Fundus photo. 45° field of view:
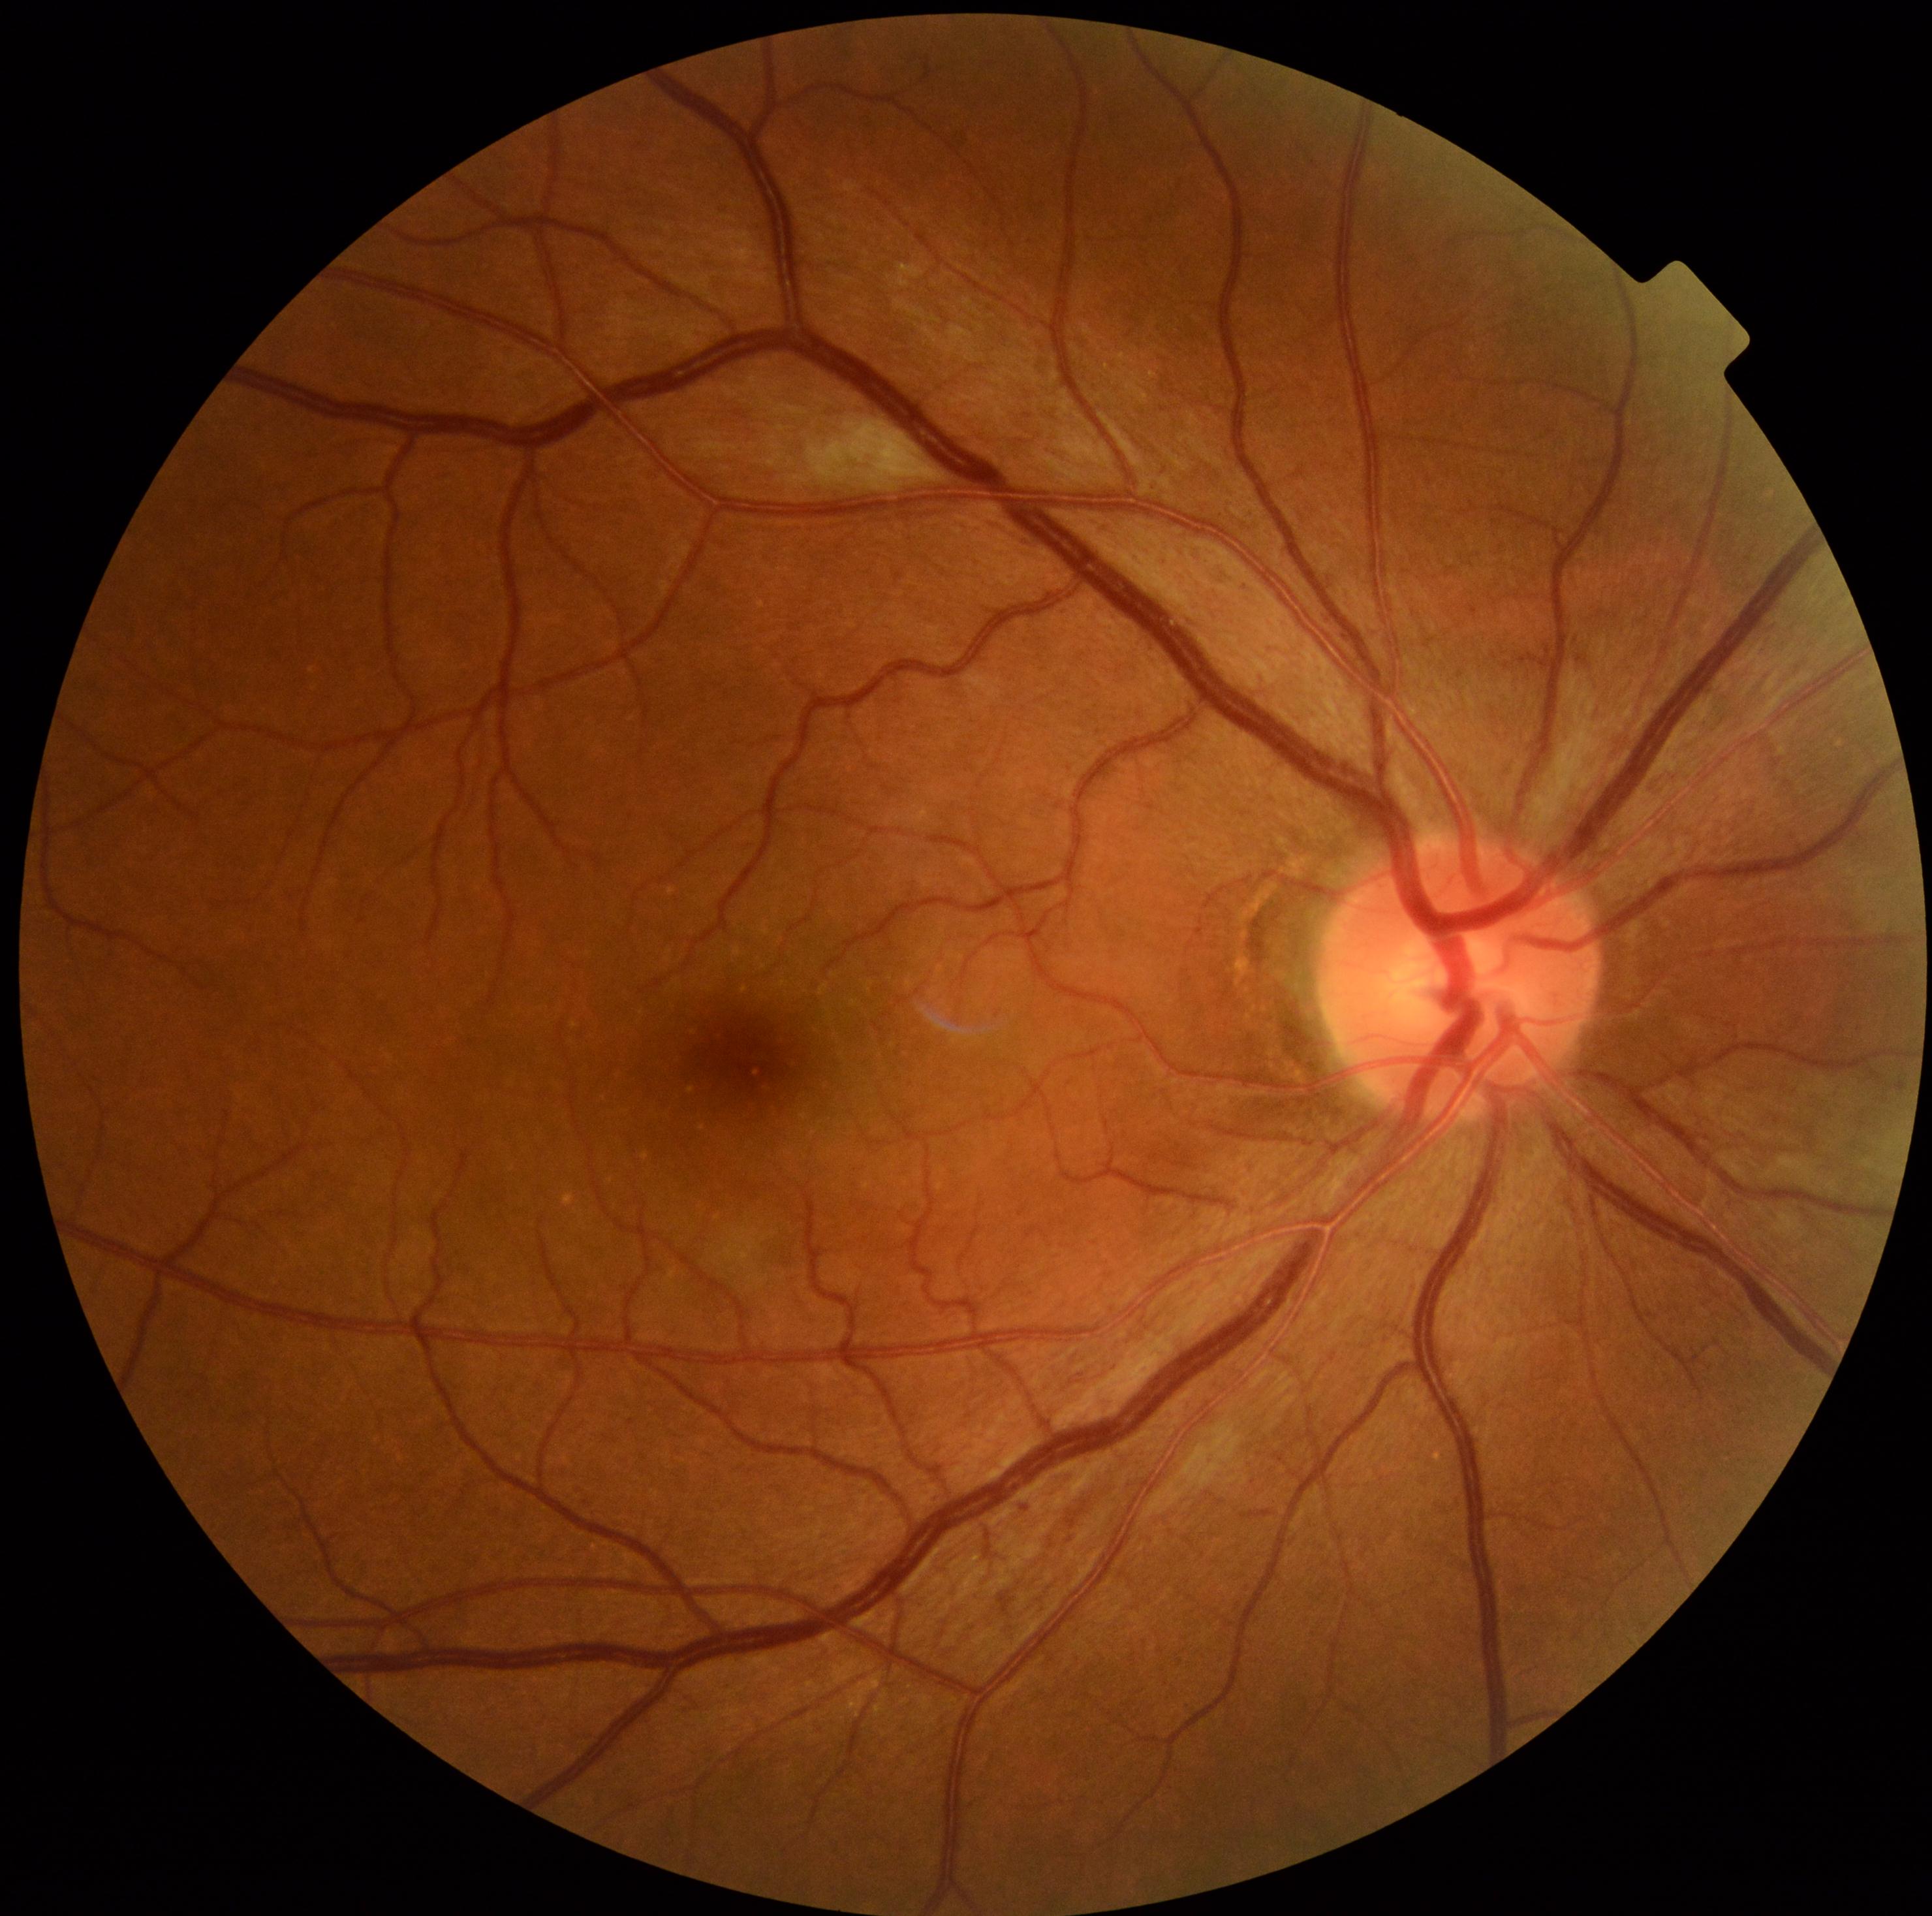   dr_grade: grade 2 (moderate NPDR)